Fundus photo — 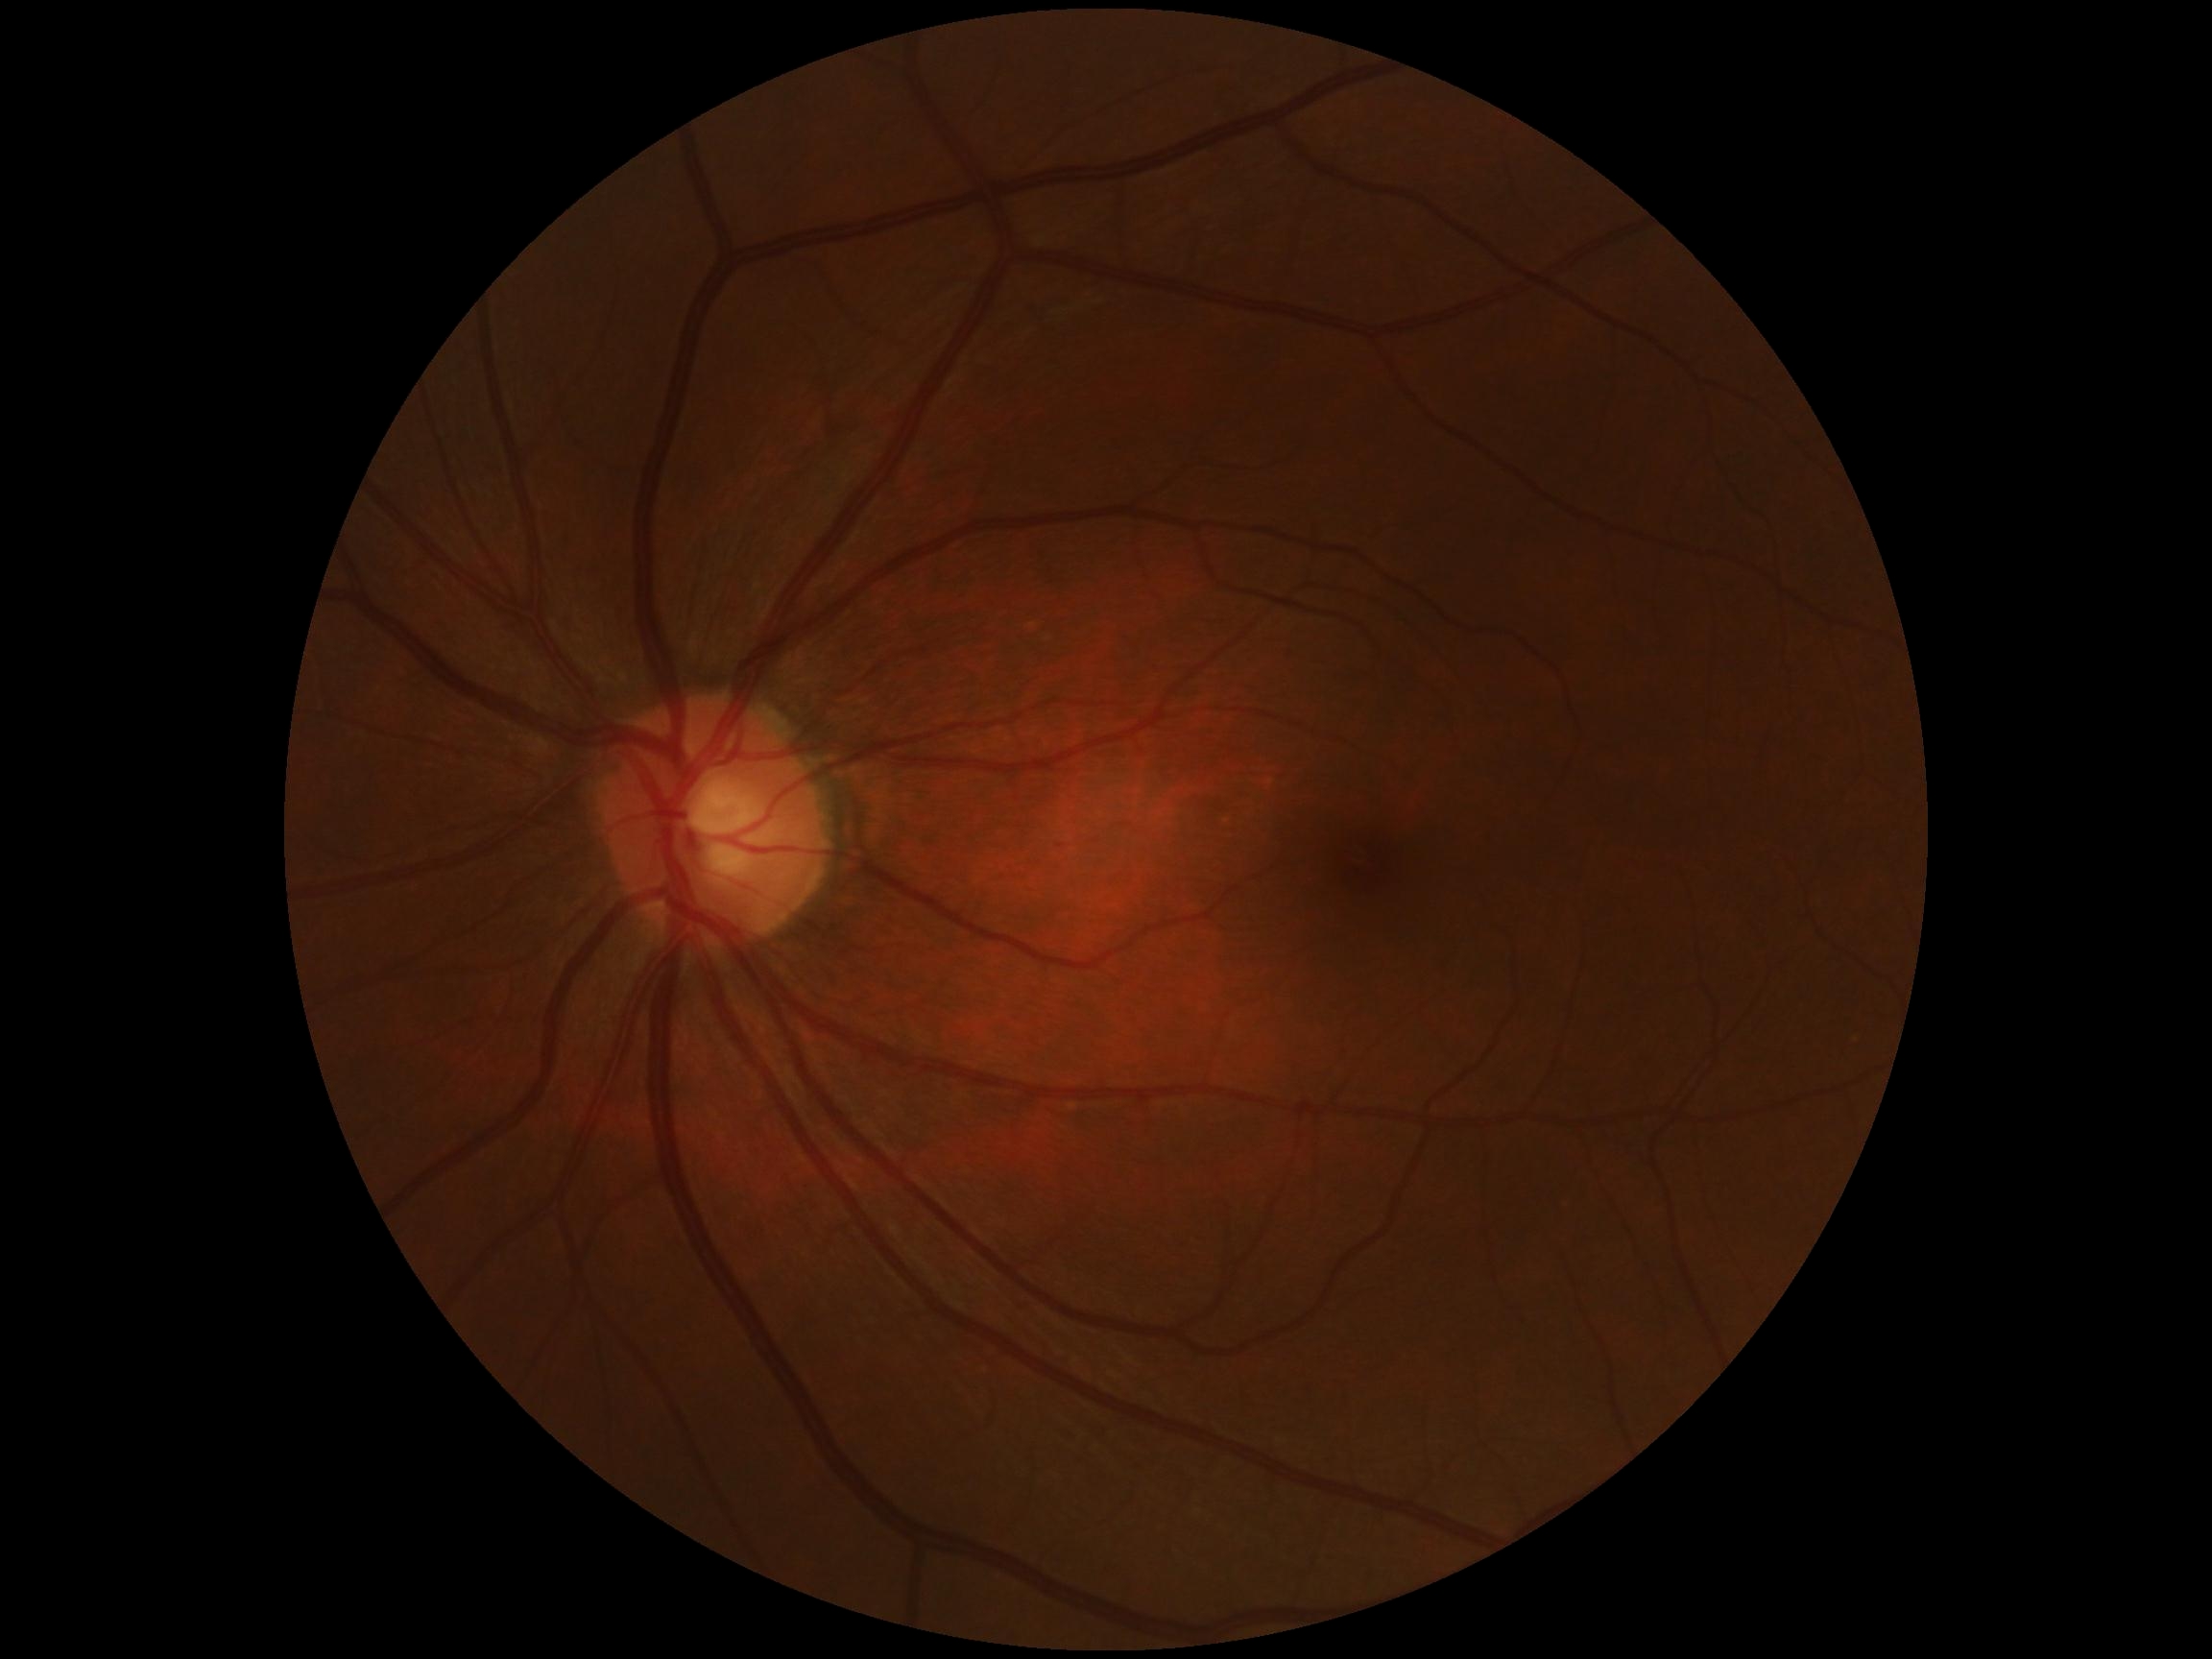 DR stage: grade 0 (no apparent retinopathy).